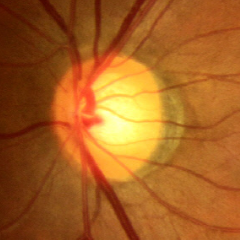 Assessment: no glaucomatous changes.